Phoenix ICON wide-field infant fundus image — 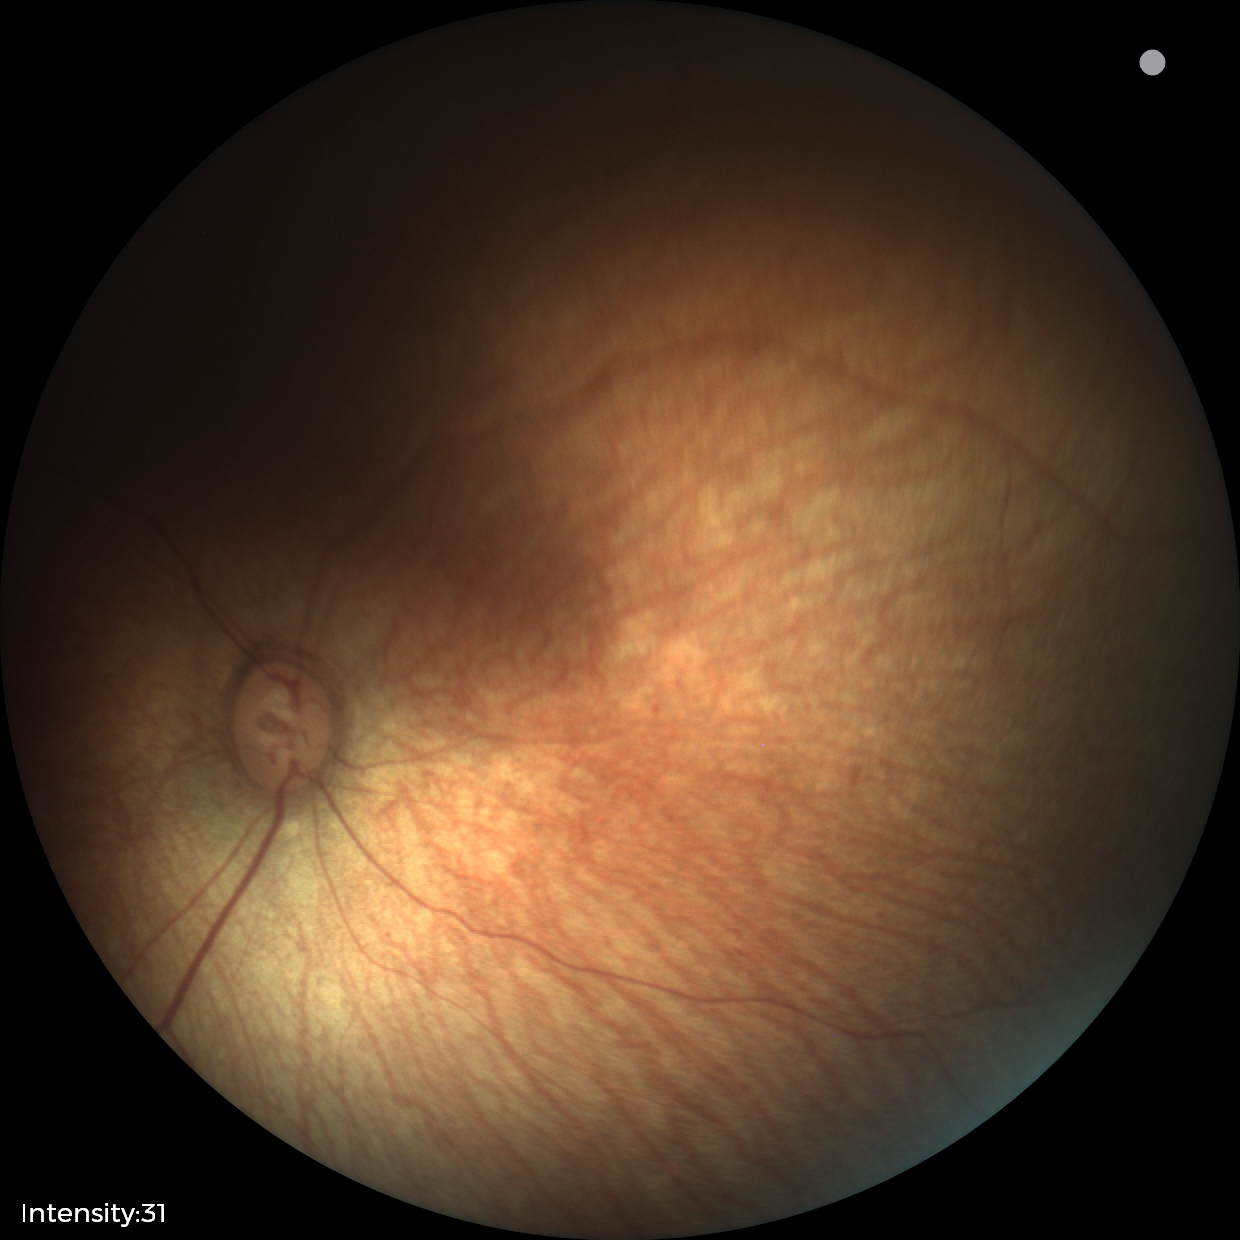
Physiological retinal appearance for postconceptual age.